Acquired on the Phoenix ICON; infant wide-field retinal image
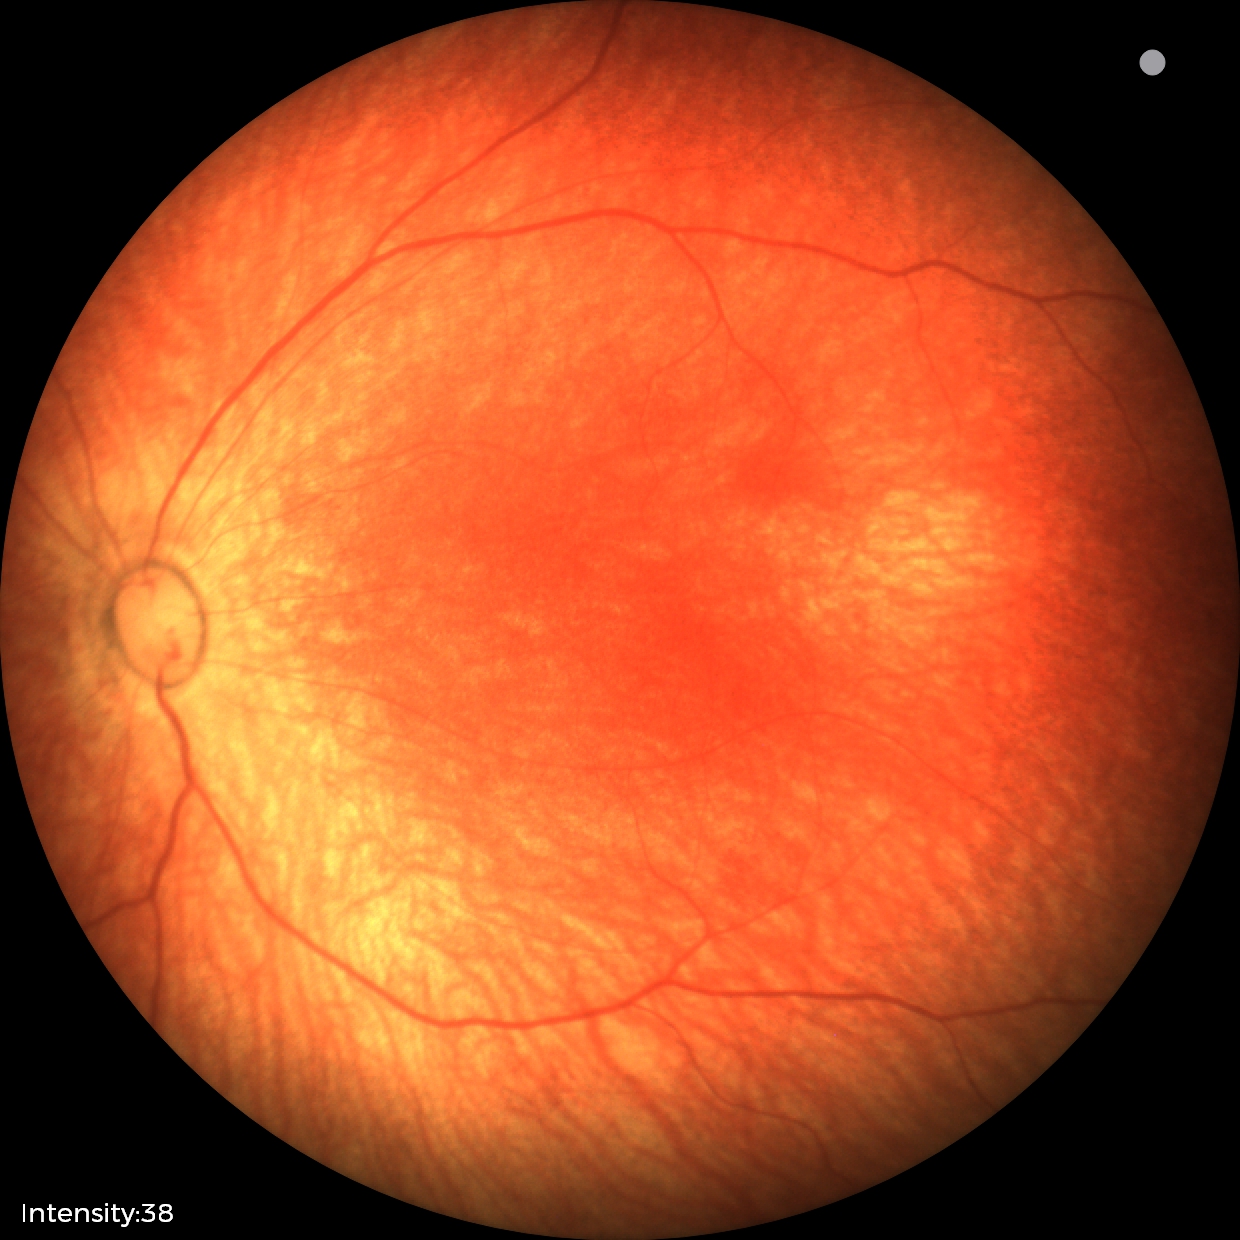
Finding = normal.